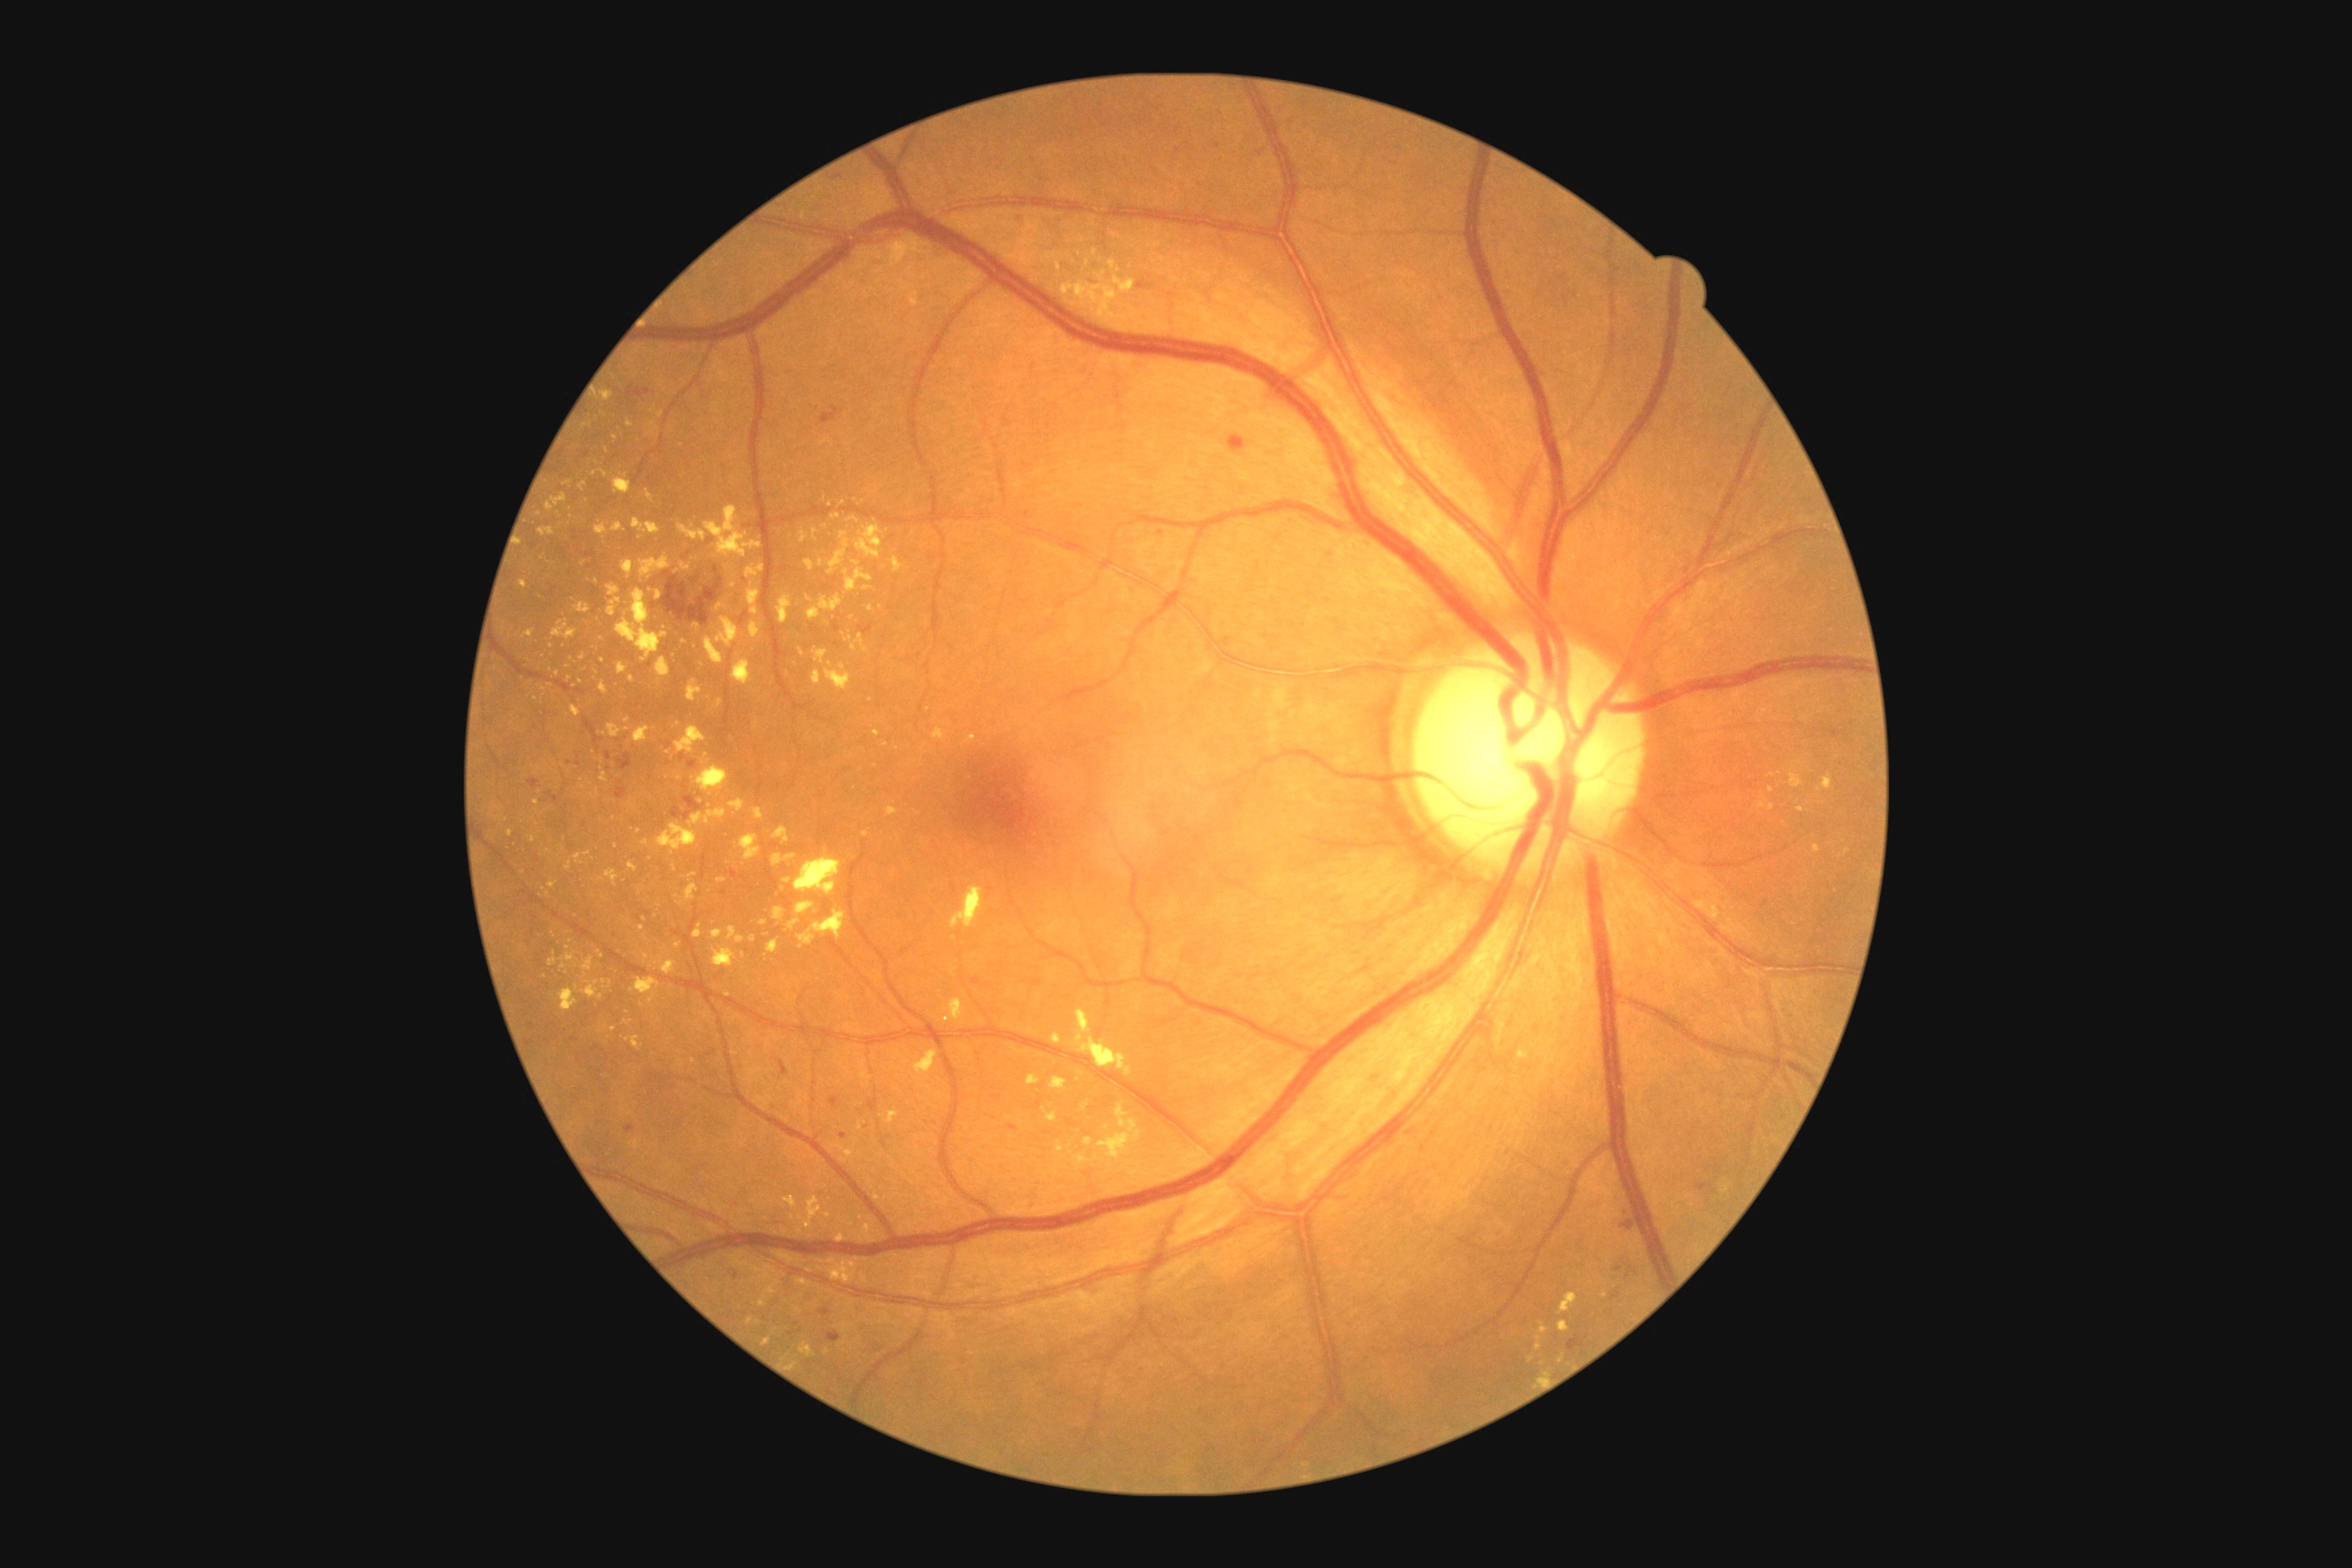

DR grade is 2; non-proliferative diabetic retinopathy
A subset of detected lesions:
EXs (more not shown): 676/564/691/574 | 1055/1142/1064/1153 | 1790/774/1805/789 | 754/808/765/819 | 598/950/603/959 | 612/475/632/495 | 745/565/765/580 | 560/965/567/974 | 828/1259/858/1284 | 656/808/727/856
Small EXs approximately at [506,821] | [532,839] | [886,745] | [720,703] | [603,983] | [831,666] | [752,585] | [544,689] | [851,1224]